Wide-field retinal mosaic image
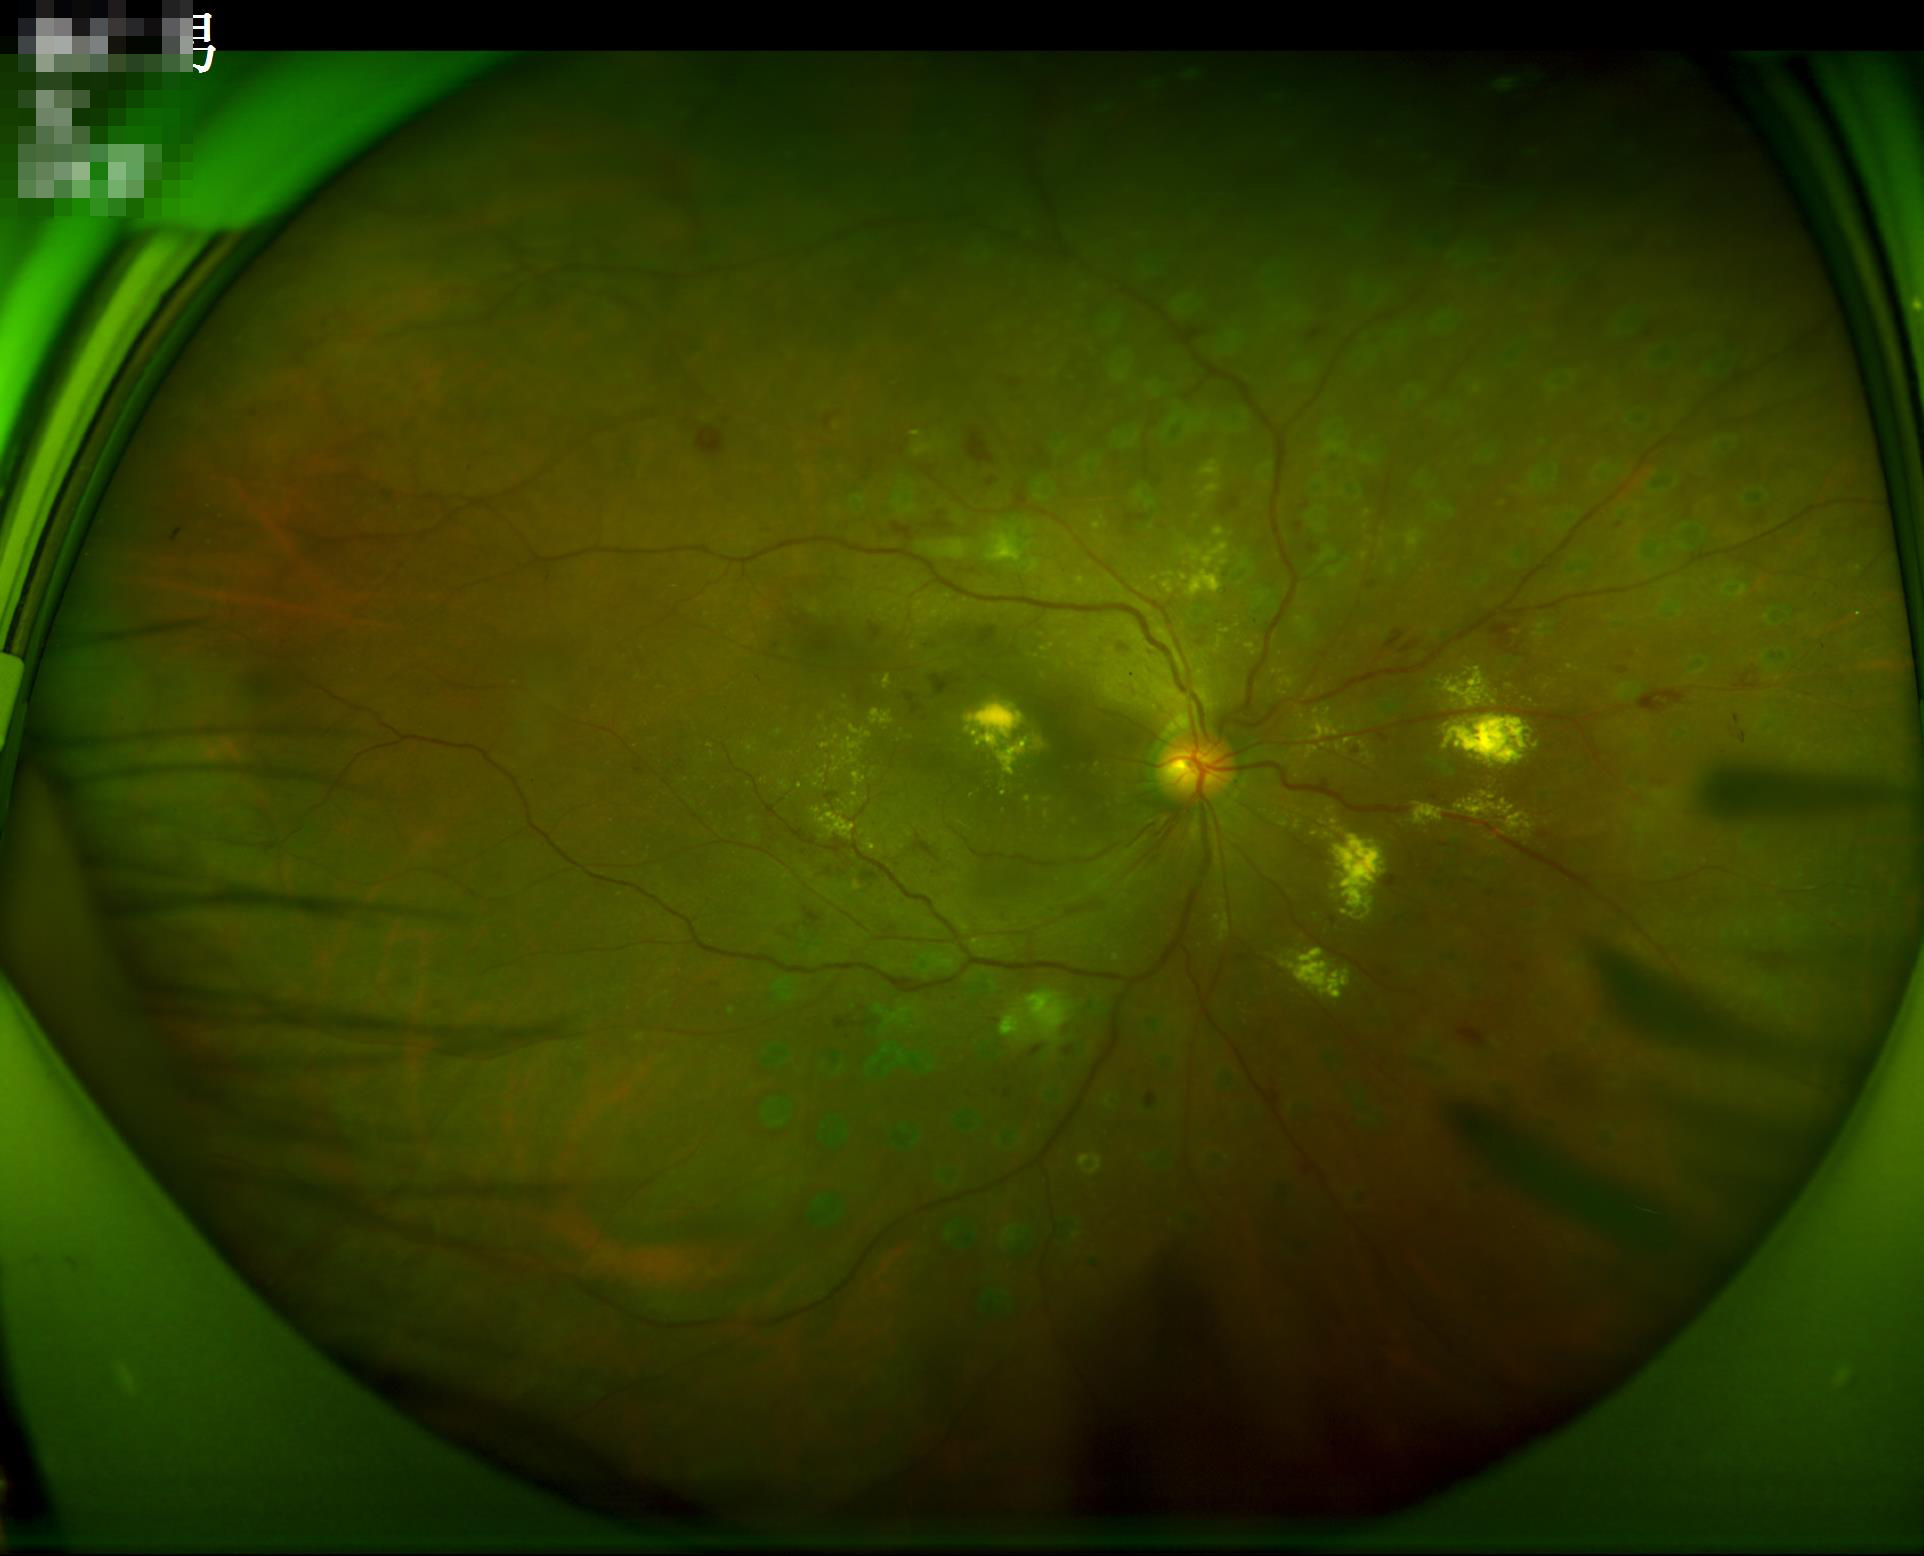

Image quality is adequate for diagnostic use. Even illumination with no color cast. Vessels and details are readily distinguishable.